Wide-field fundus image from infant ROP screening. 1240 x 1240 pixels
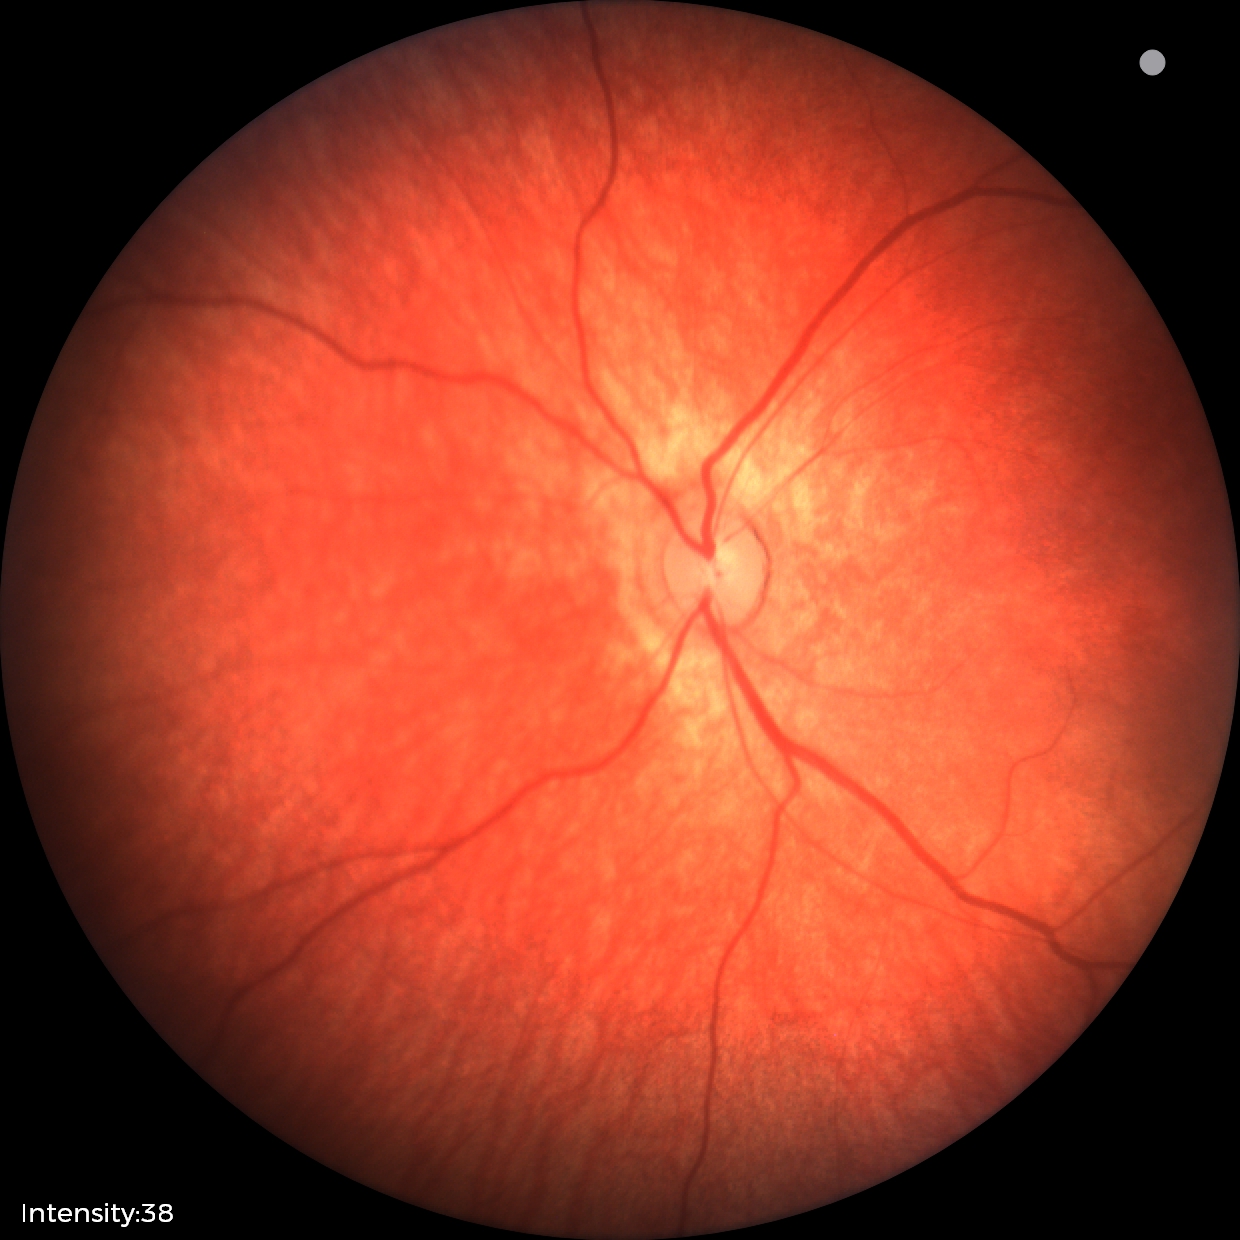 Physiological retinal appearance for postconceptual age.